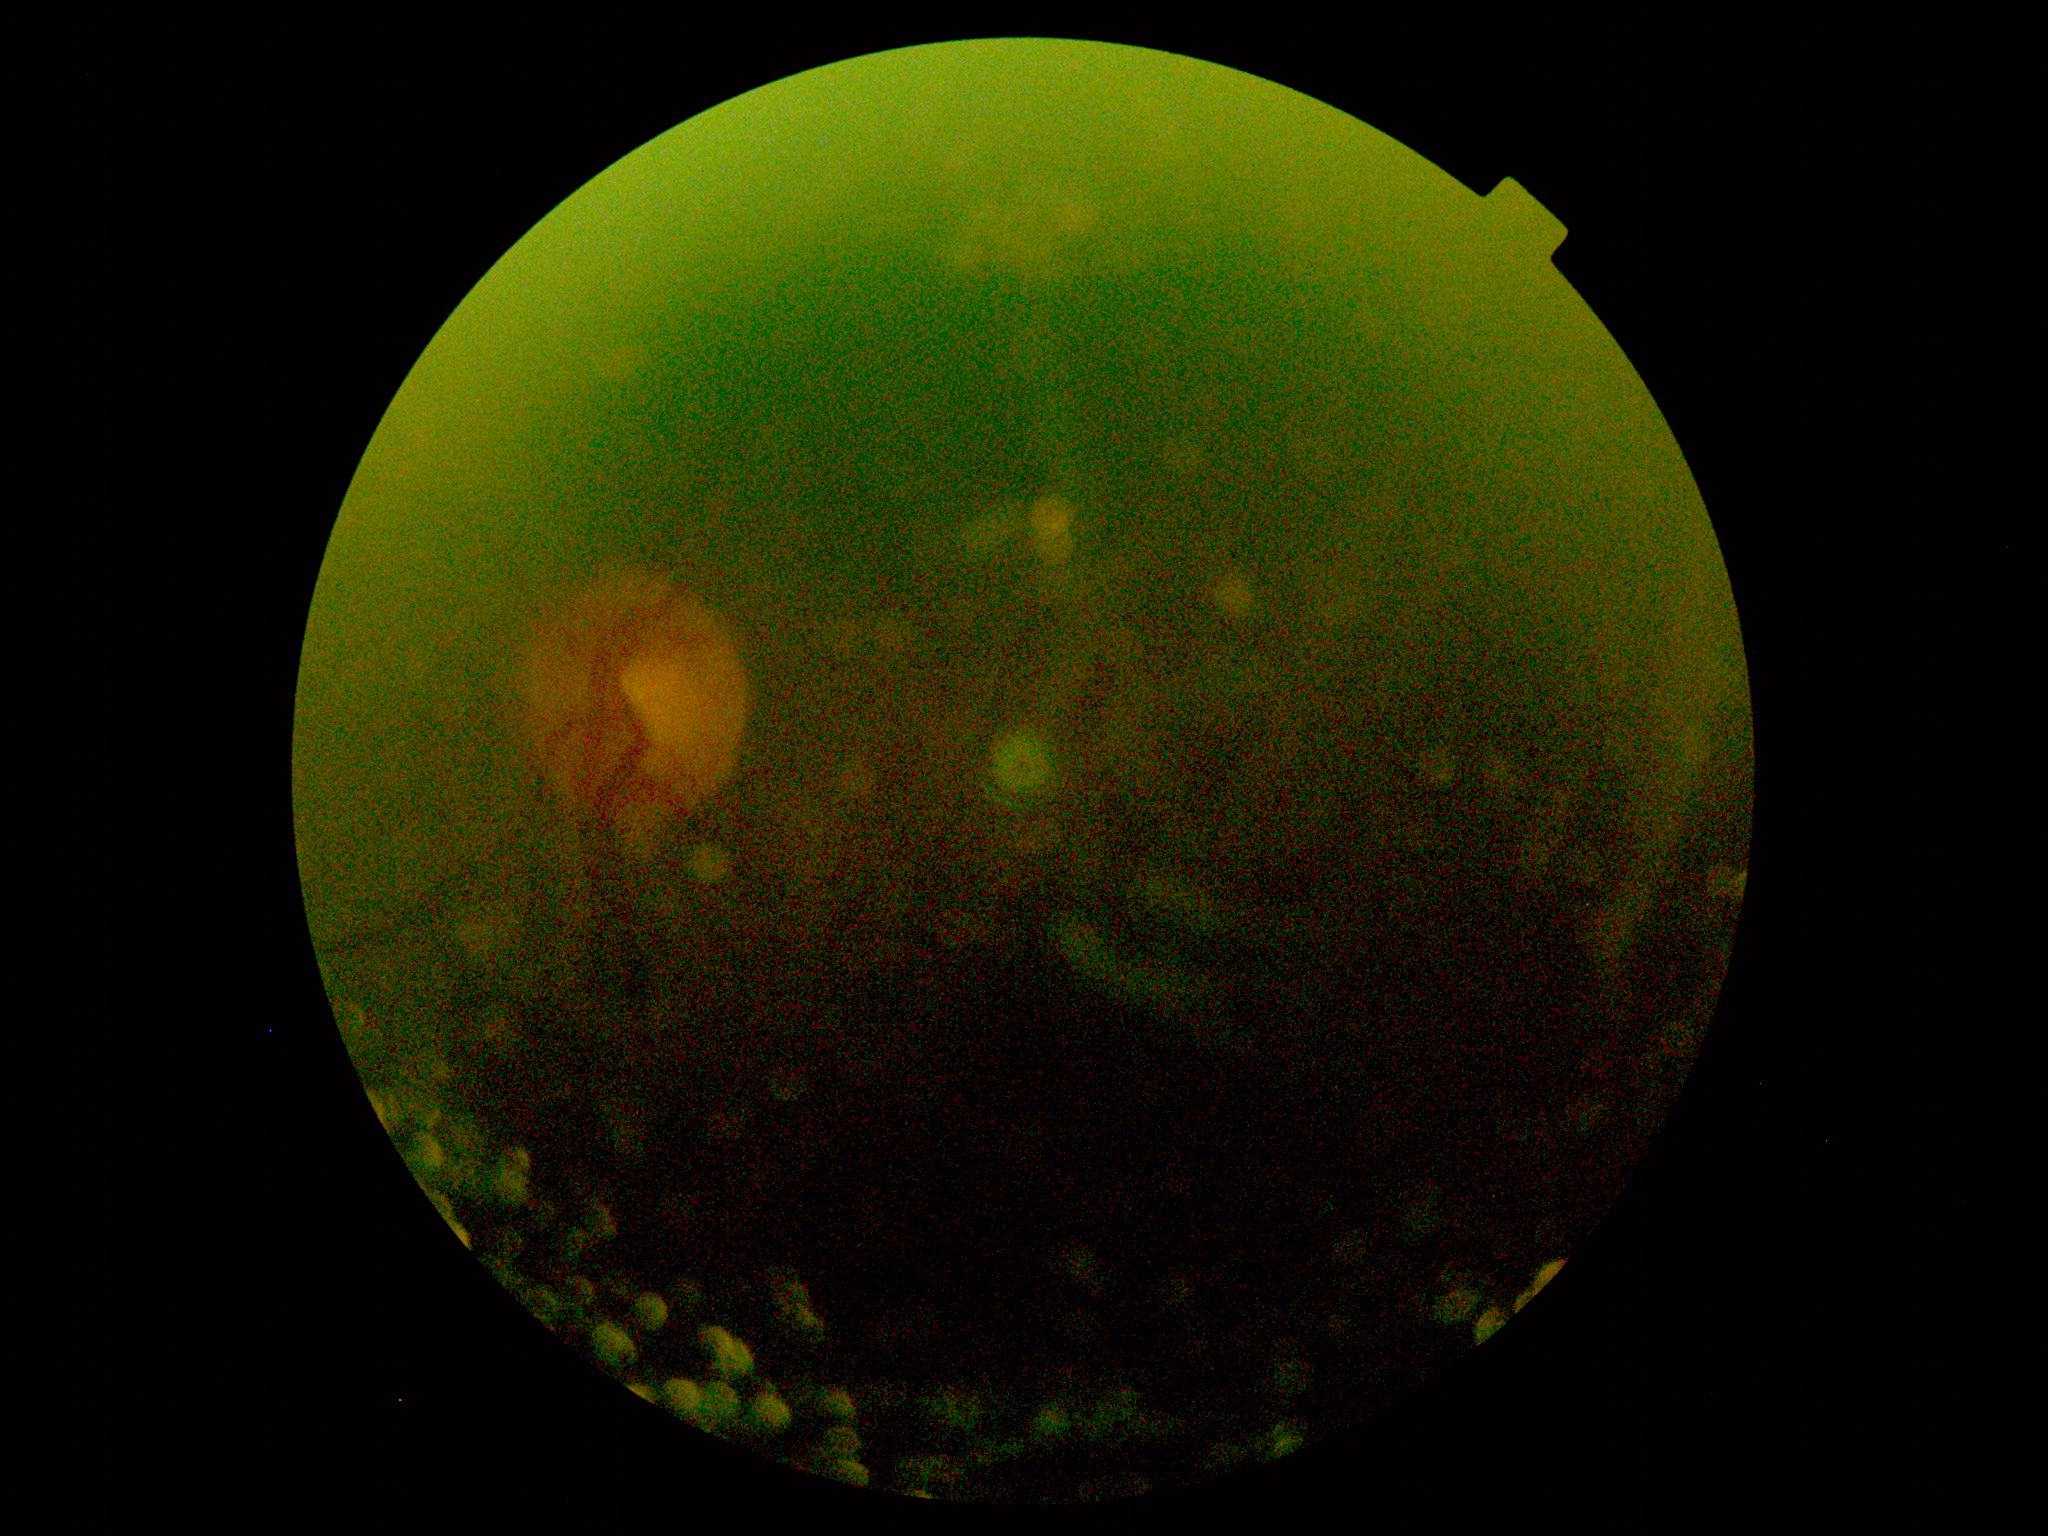

DR is ungradable due to poor image quality.